FOV: 45 degrees: 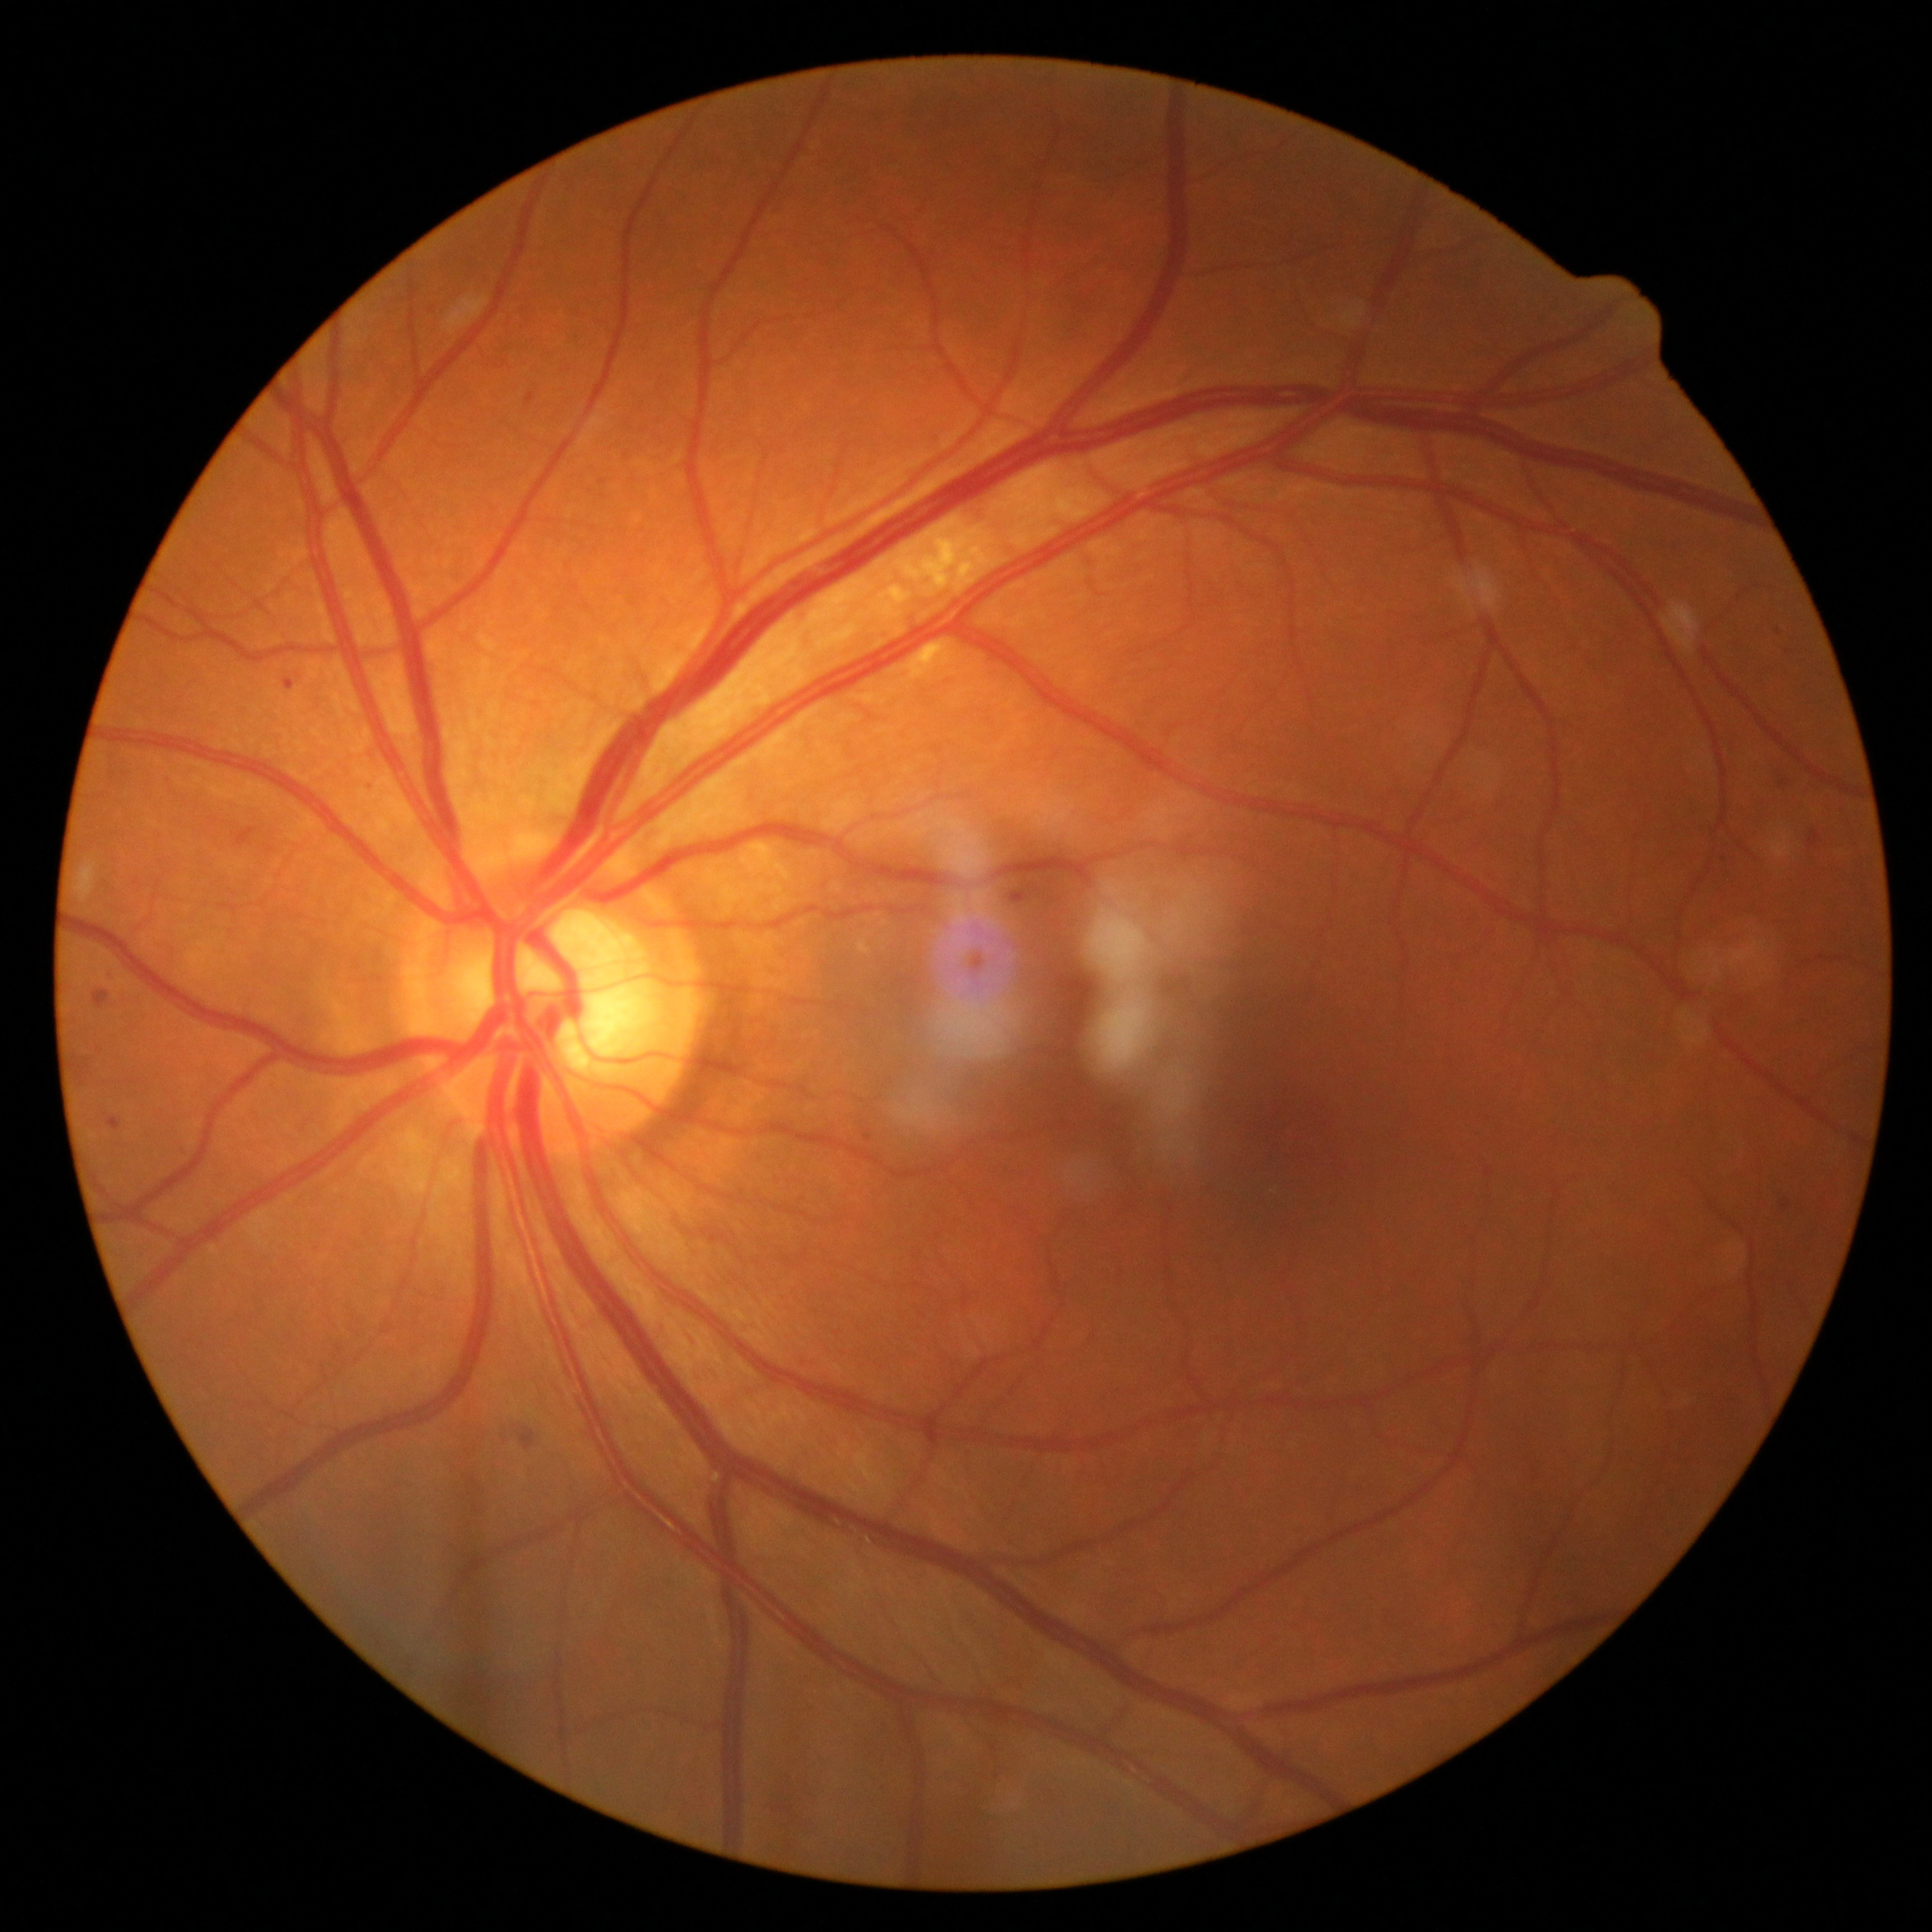

Annotations:
• DR stage — grade 2 (moderate NPDR)